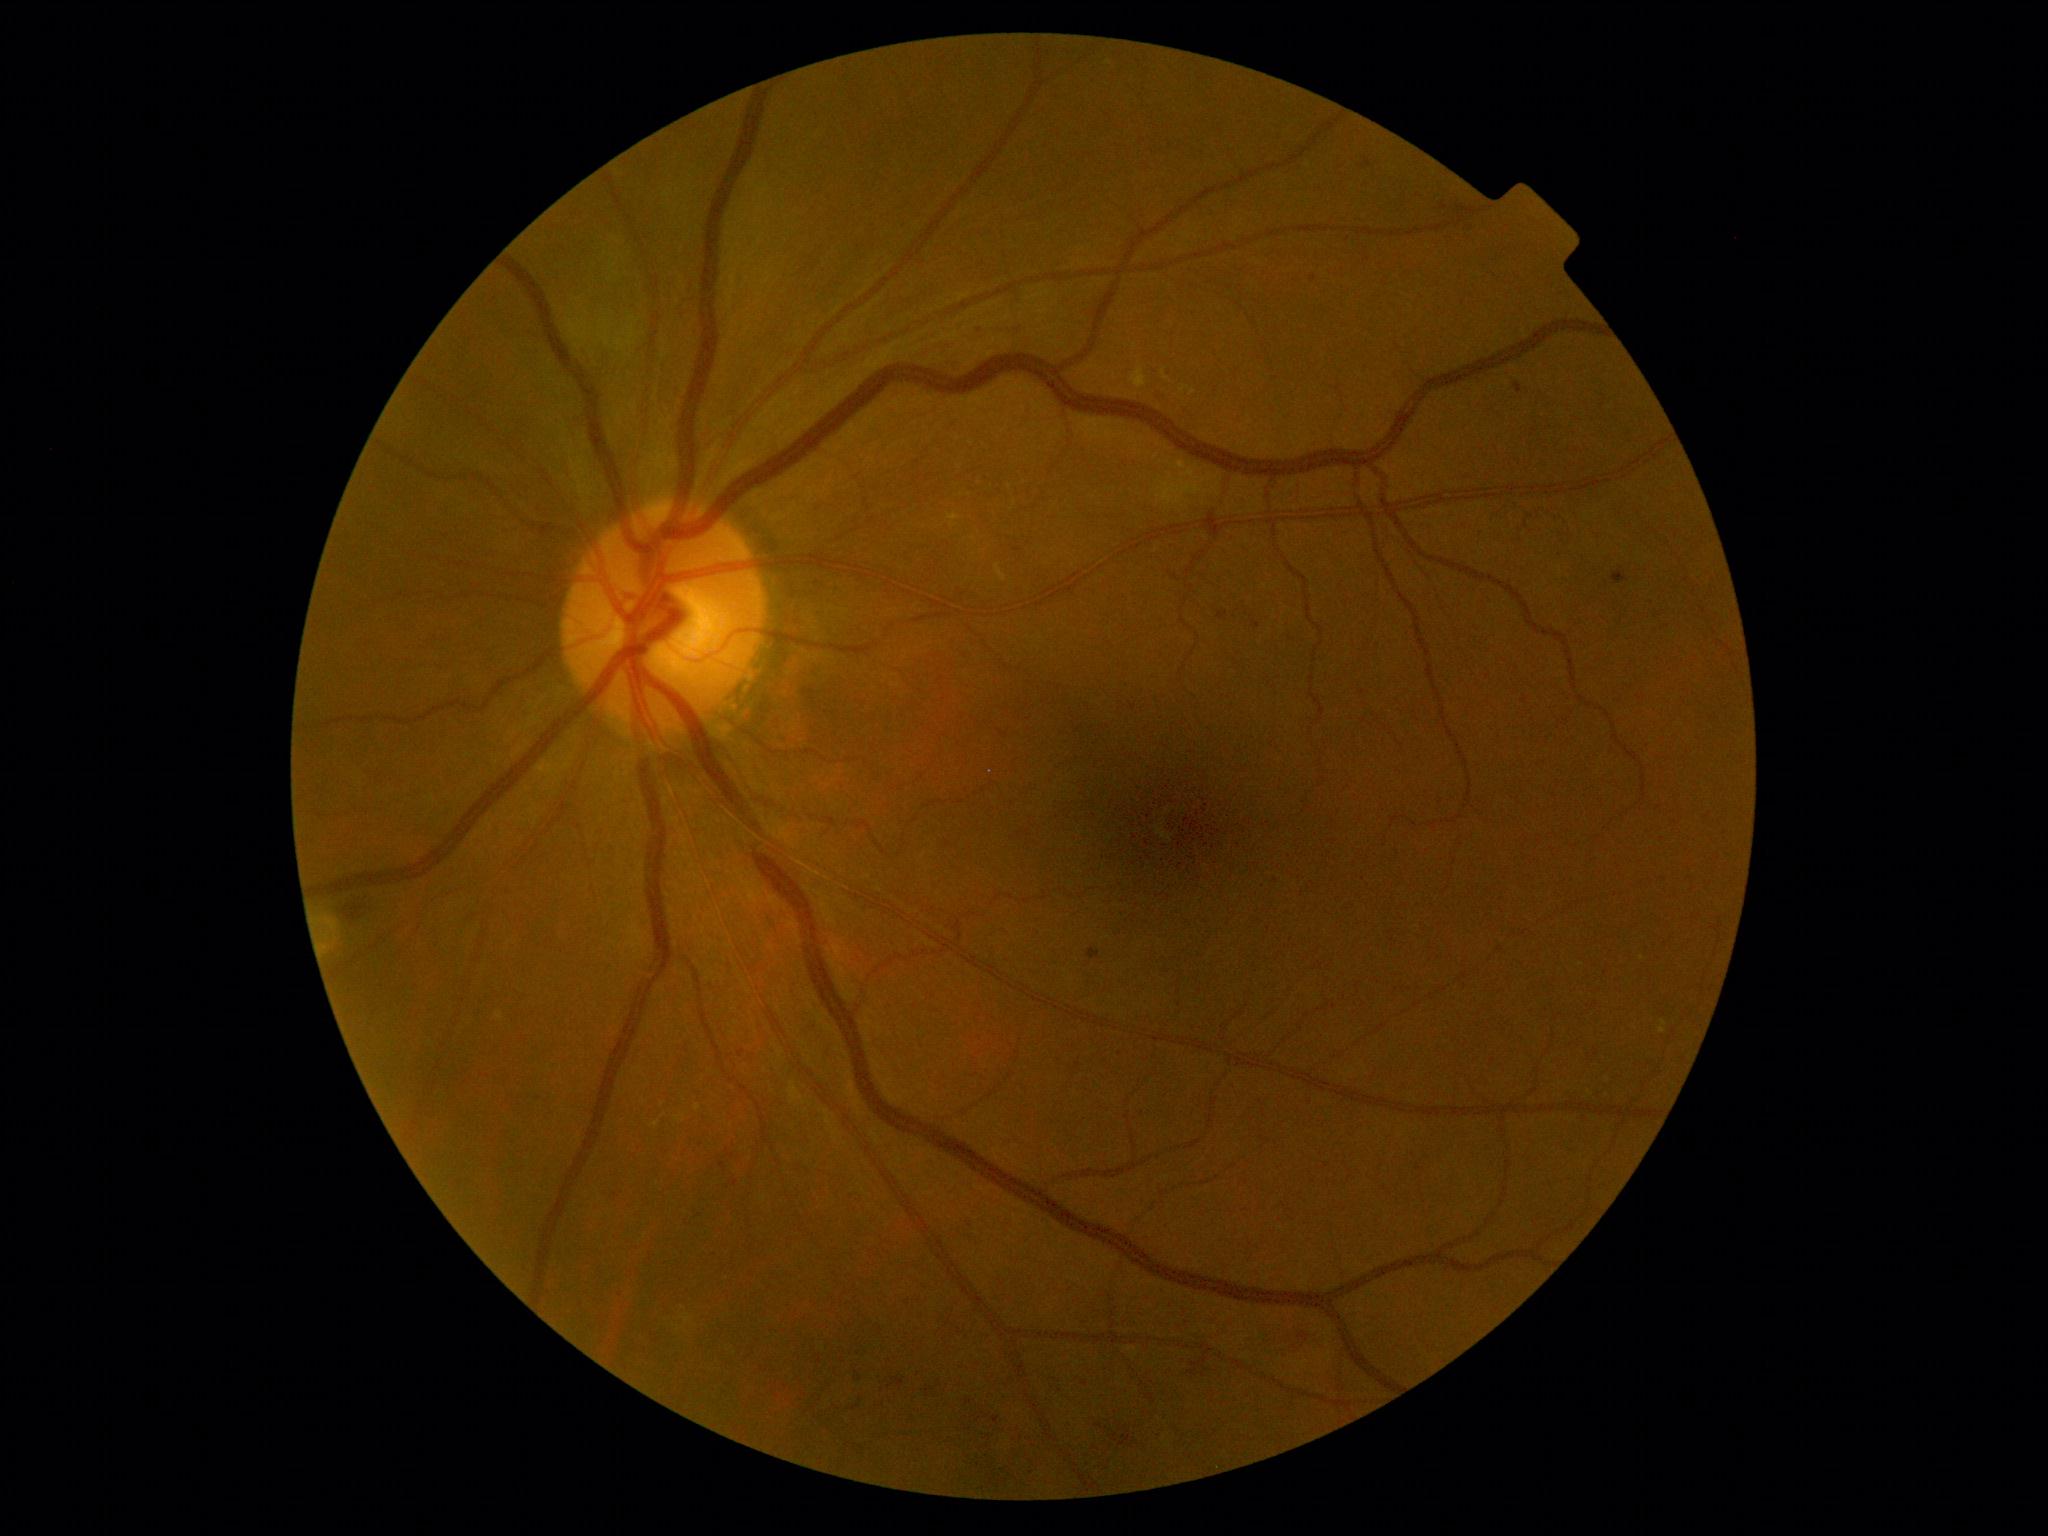

DR grade: 2 — more than just microaneurysms but less than severe NPDR.